FOV: 45 degrees · without pupil dilation · camera: NIDEK AFC-230:
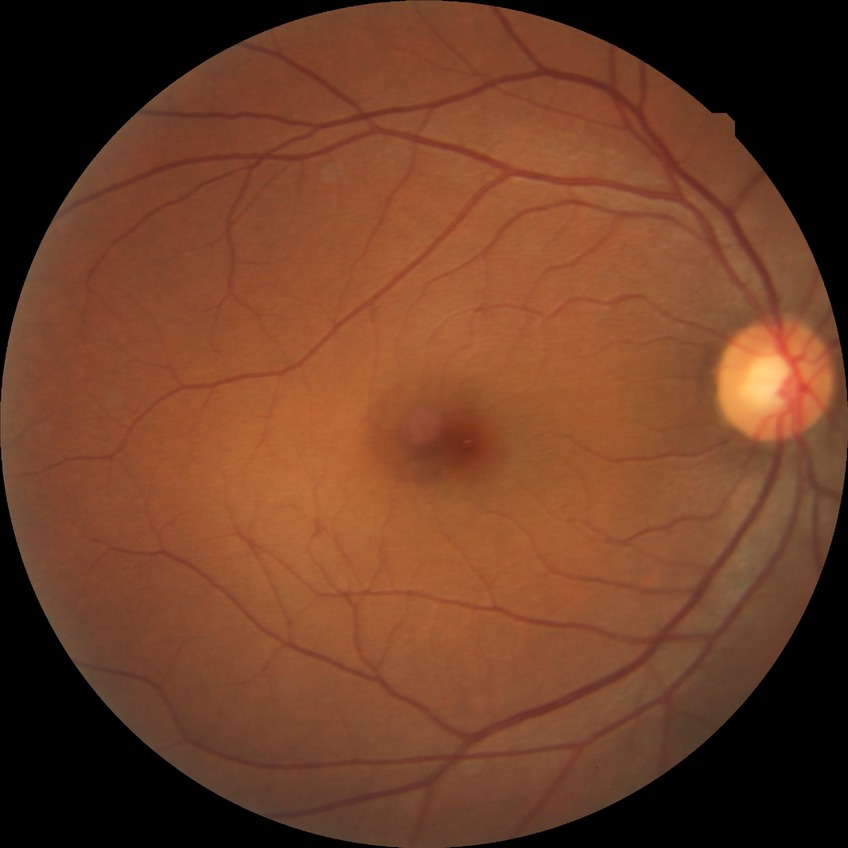 Diabetic retinopathy (DR): NDR (no diabetic retinopathy).